45-degree field of view; 2352 by 1568 pixels; retinal fundus photograph
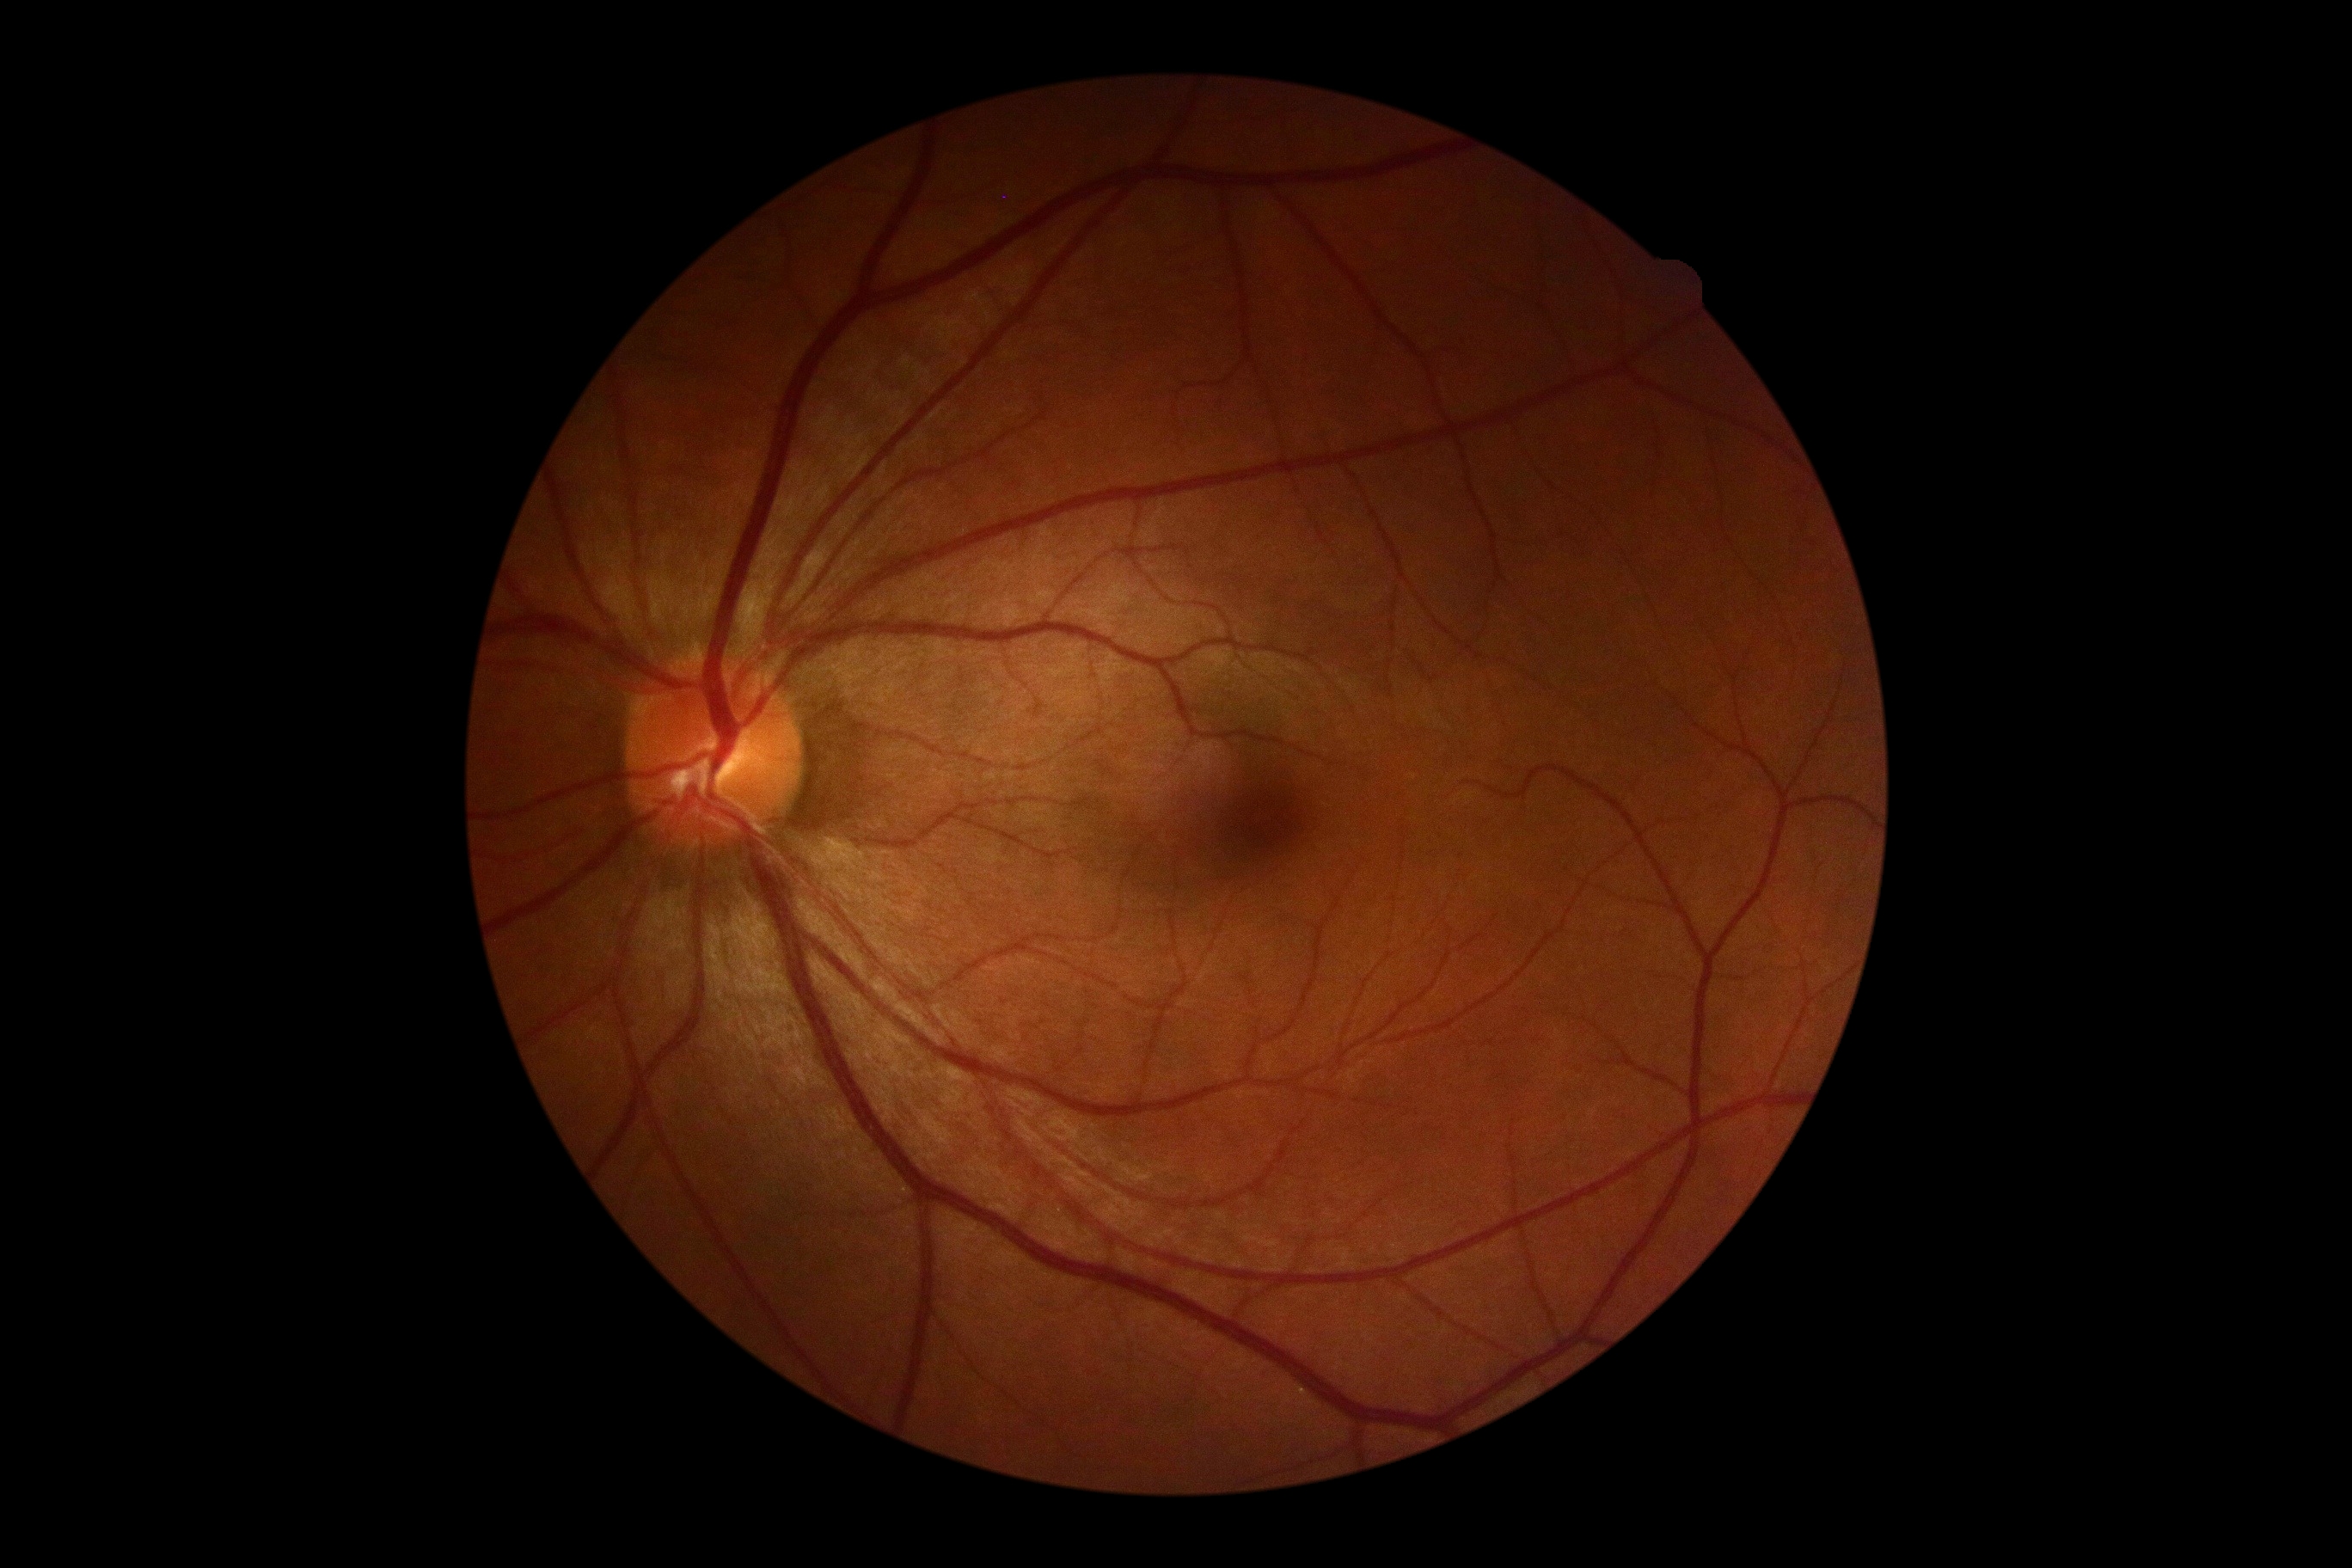 retinopathy grade: no apparent retinopathy (0).